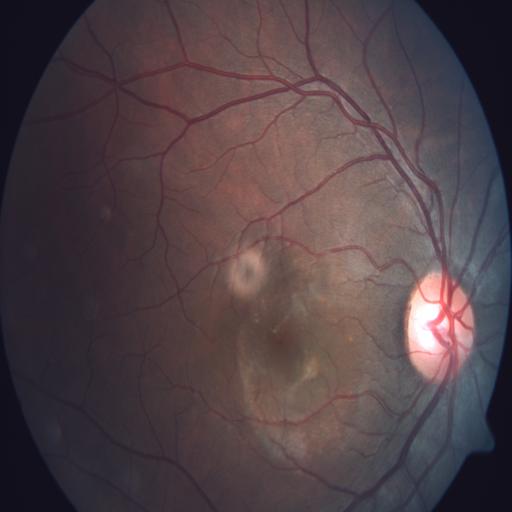 Impression: tilted disc.